NIDEK AFC-230 fundus camera:
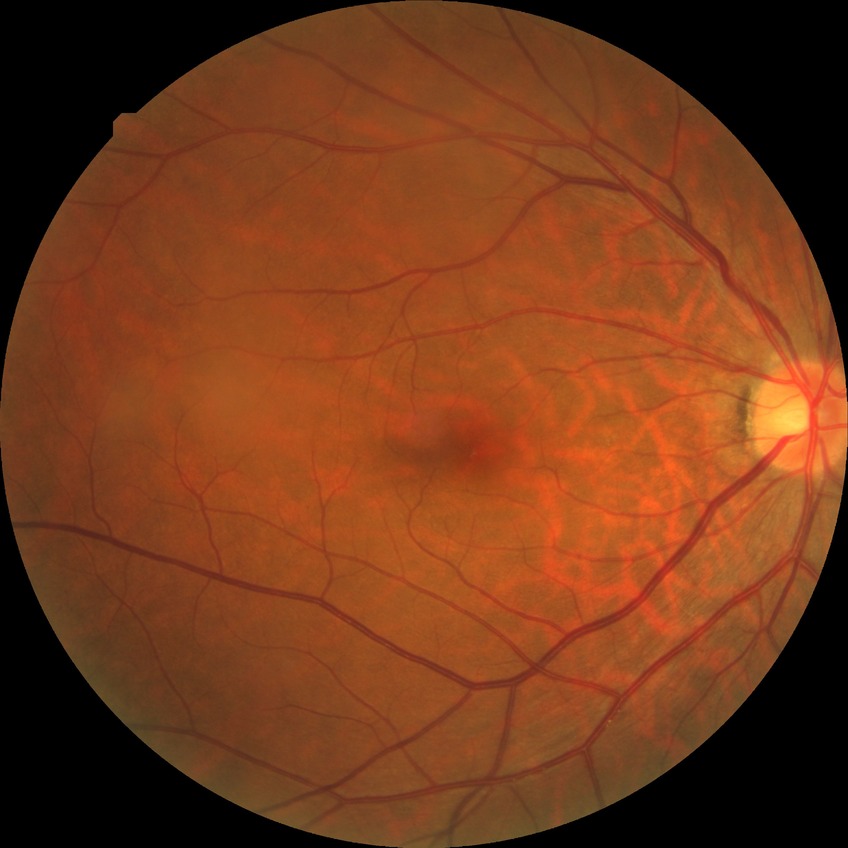
Diabetic retinopathy (DR): no diabetic retinopathy (NDR).